2212x1659px:
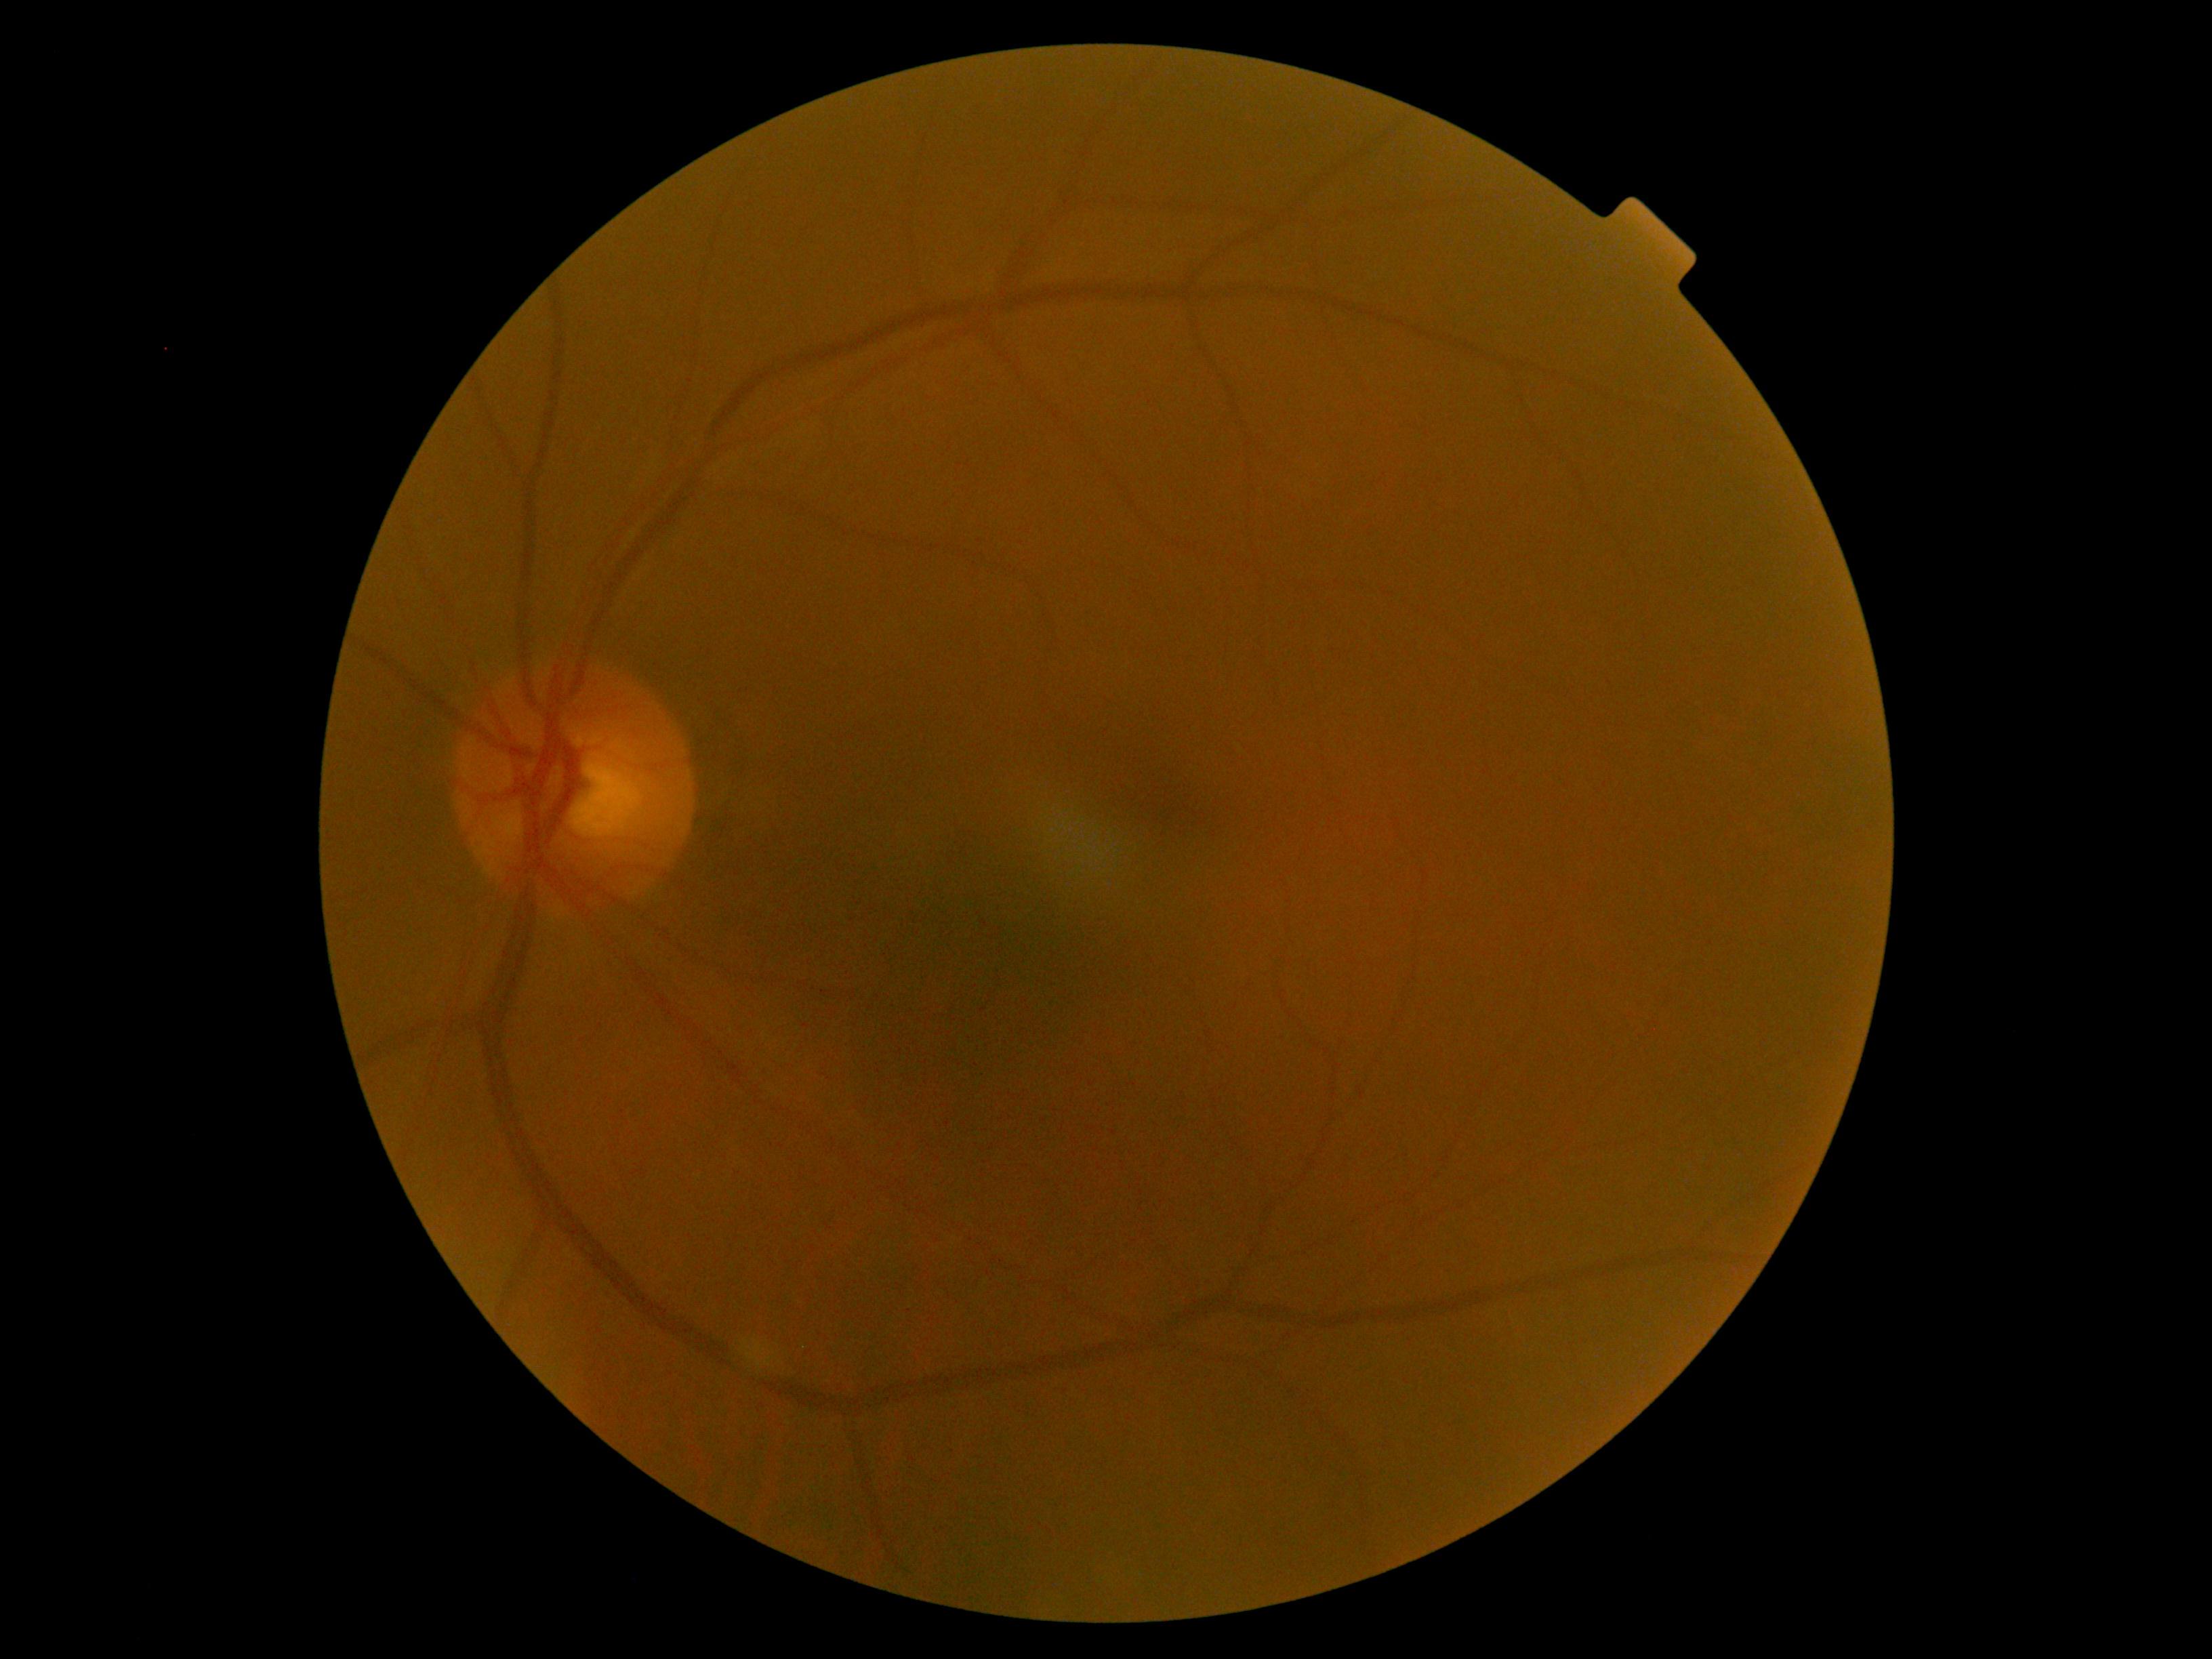
{"dr_grade": "no apparent diabetic retinopathy (grade 0)"}